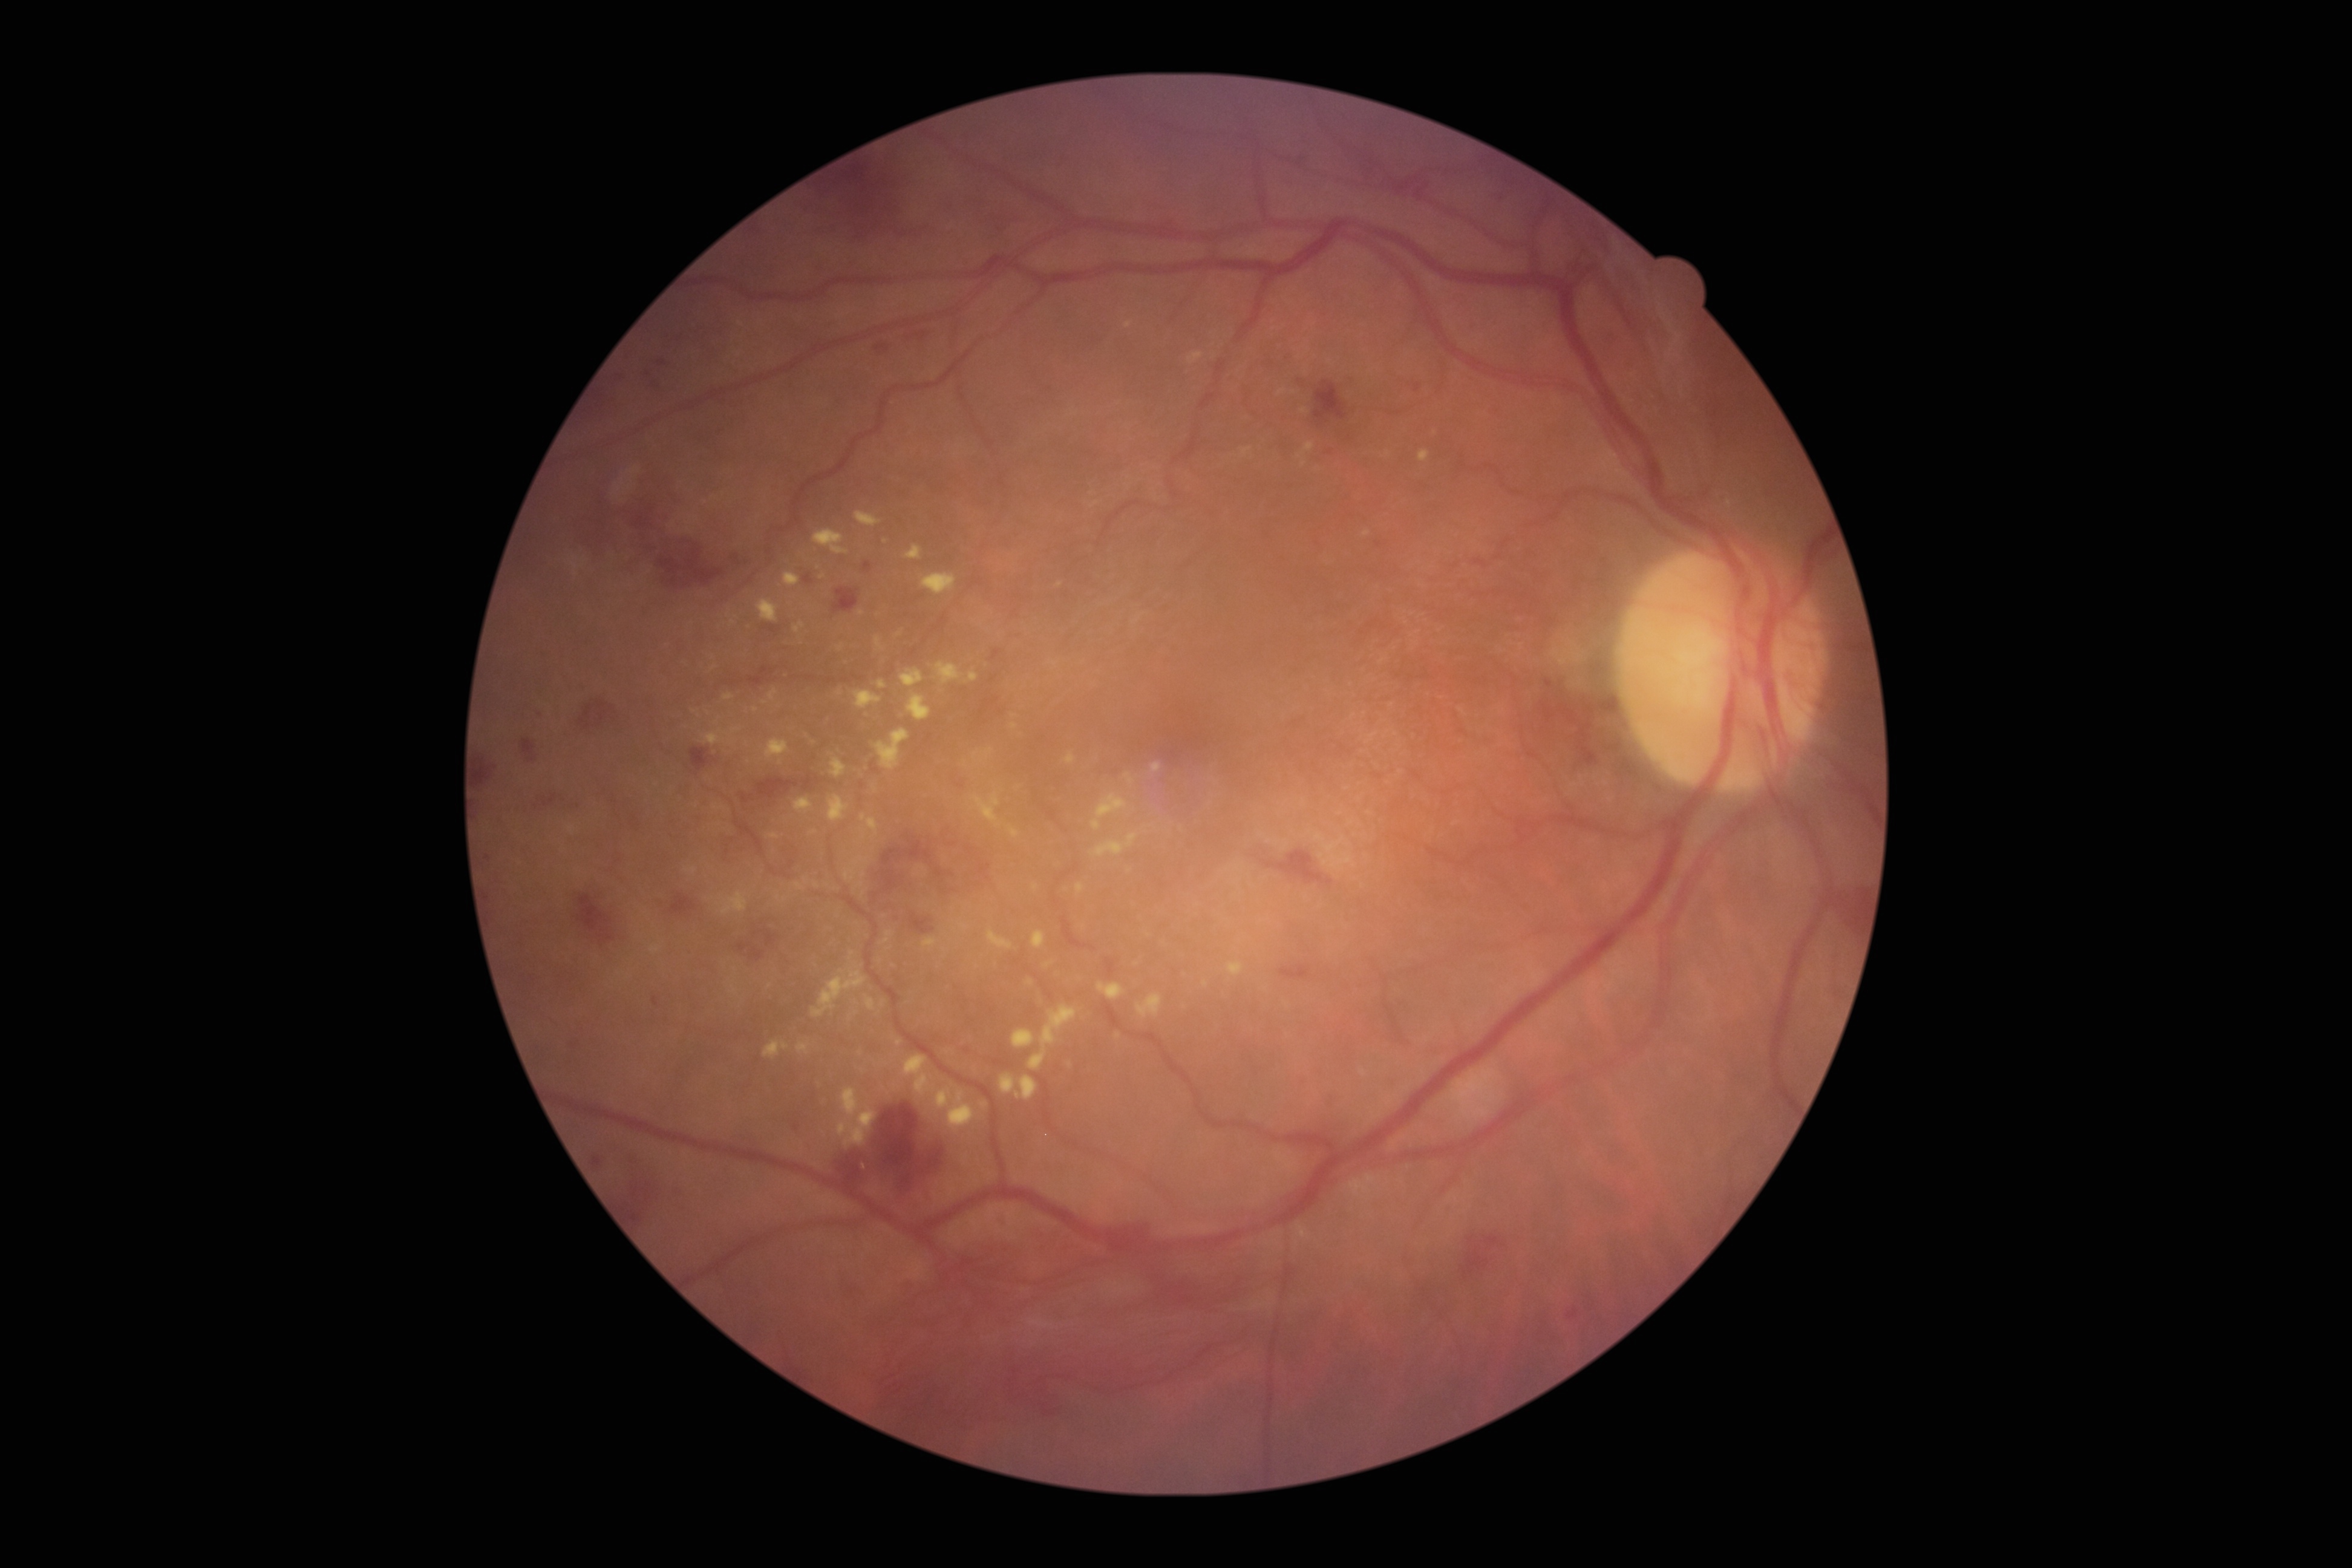 DR grade: 4 (PDR) — neovascularization and/or vitreous/pre-retinal hemorrhage.